2352 x 1568 pixels — 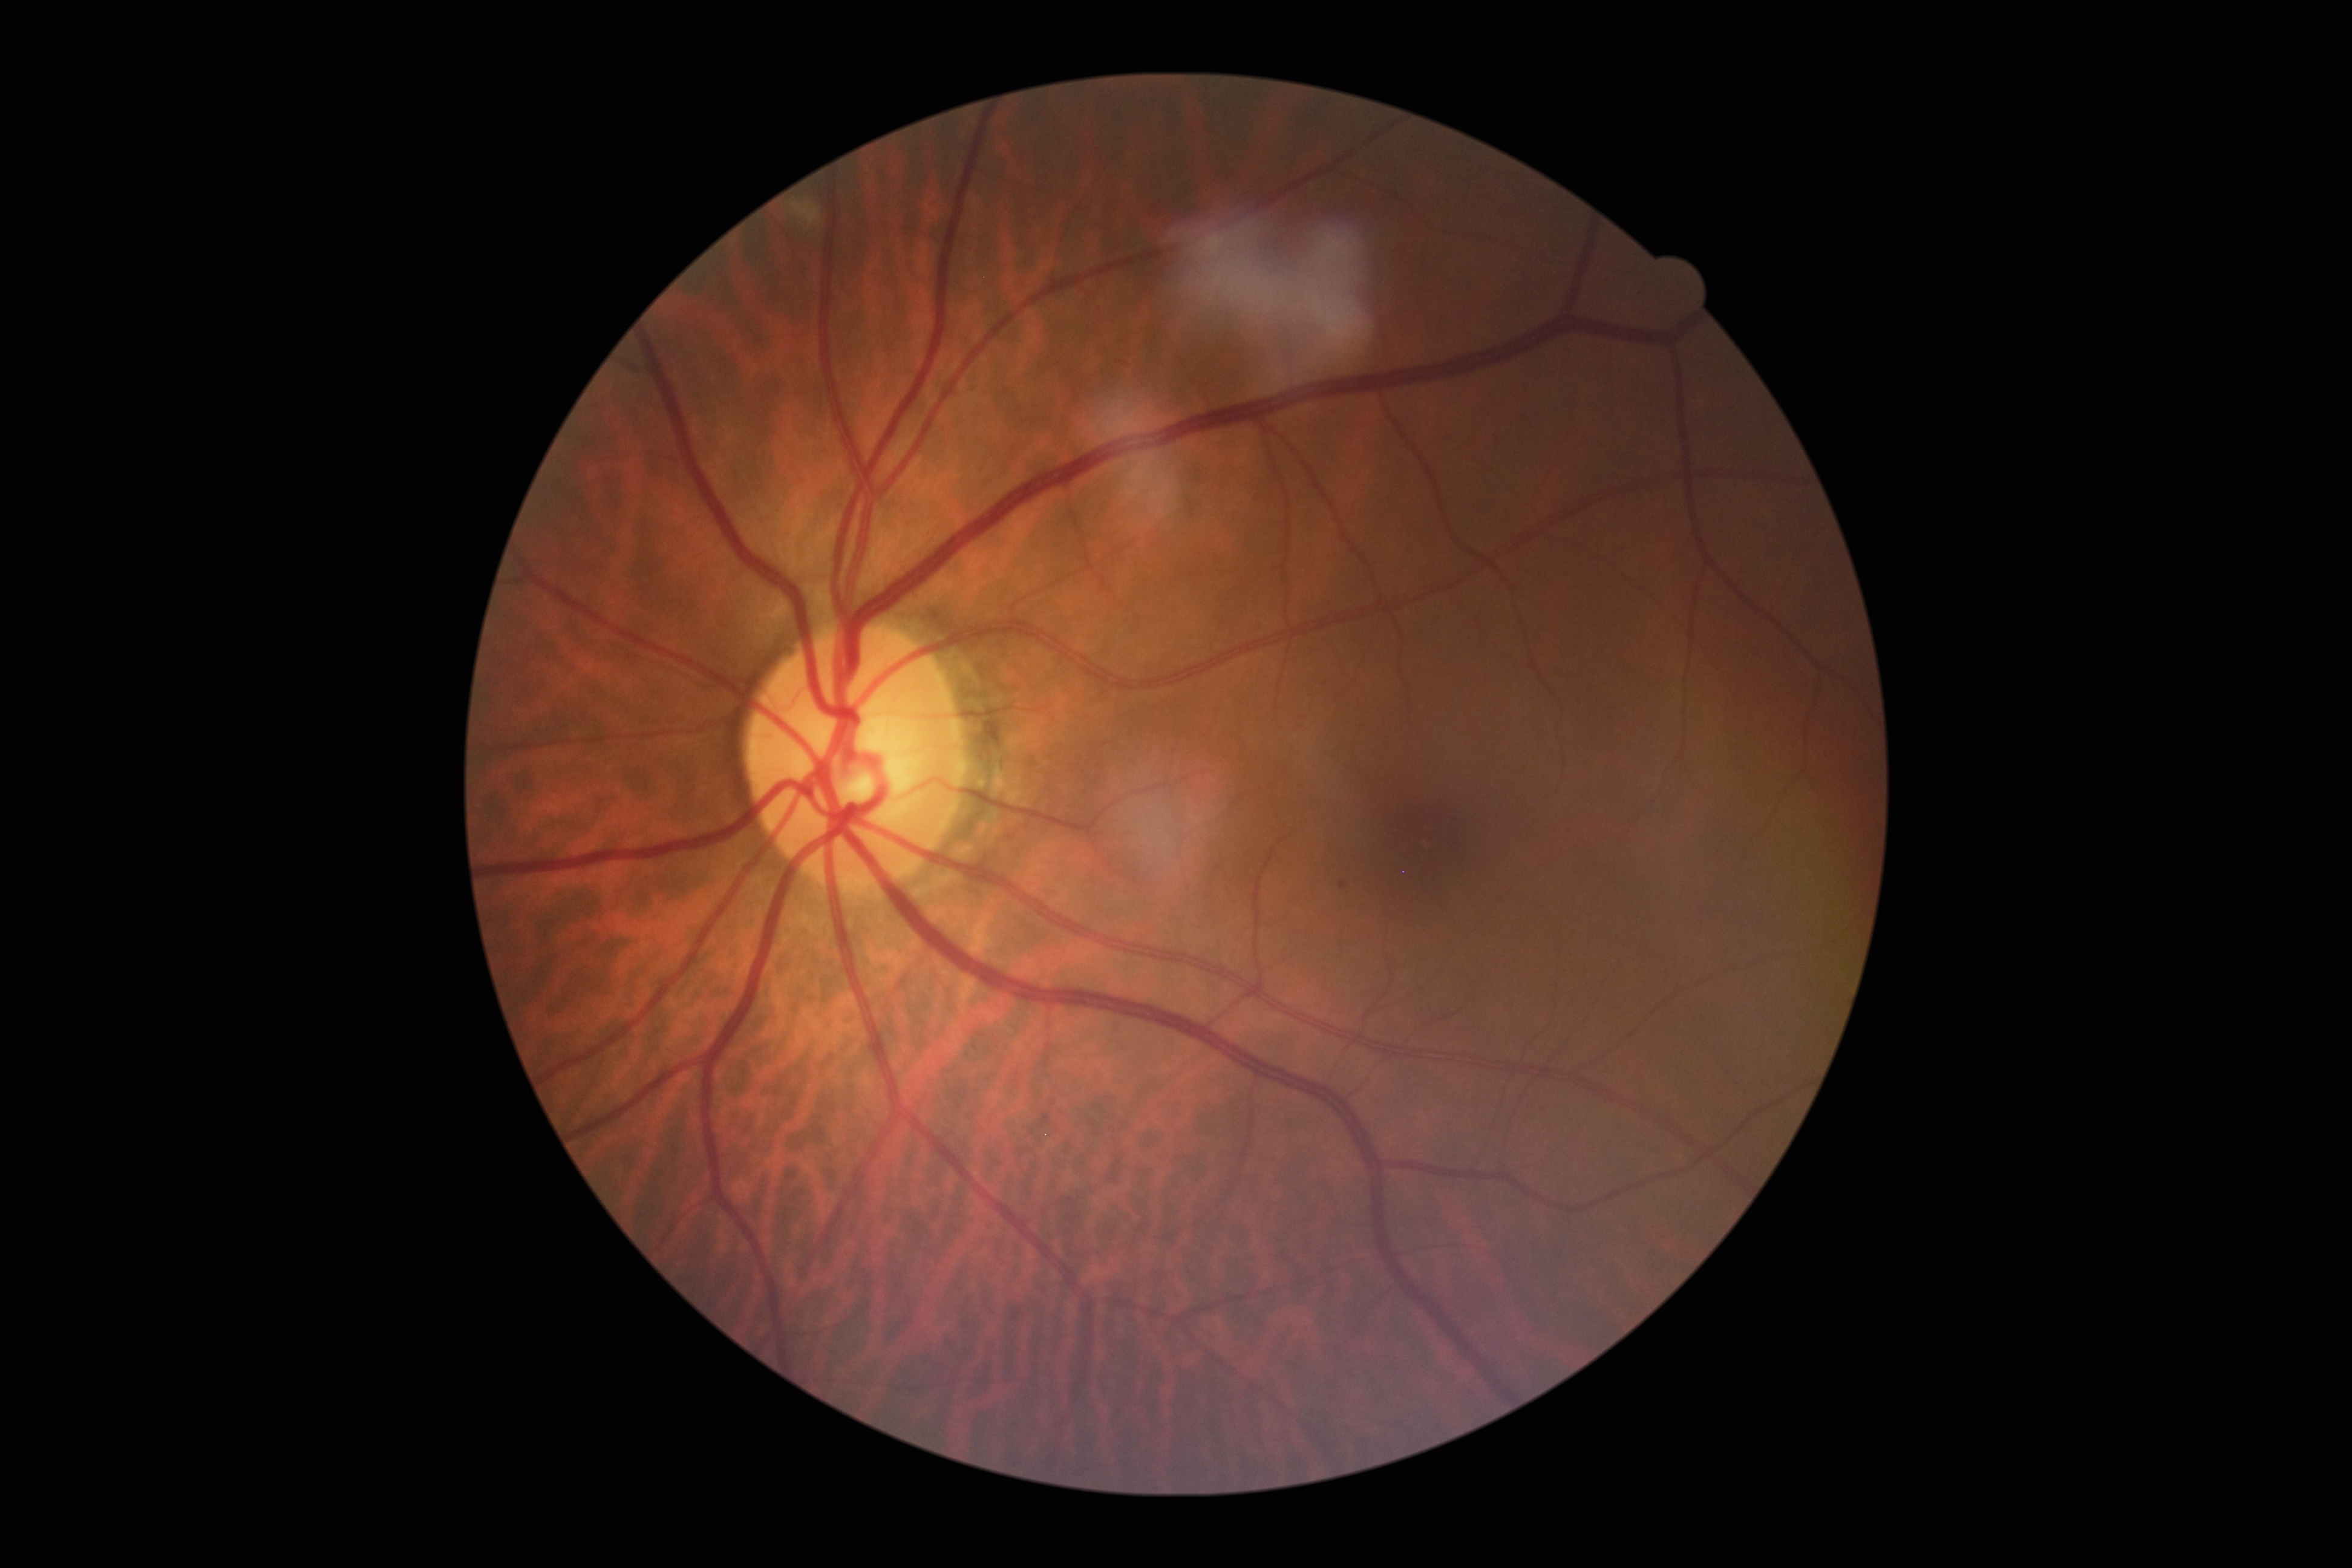 – diabetic retinopathy severity: grade 2 — more than just microaneurysms but less than severe NPDR